Refraction: -4.5 -0.25 × 11°. Intraocular pressure 15 mmHg (non-contact tonometry). Pachymetry 516 µm.
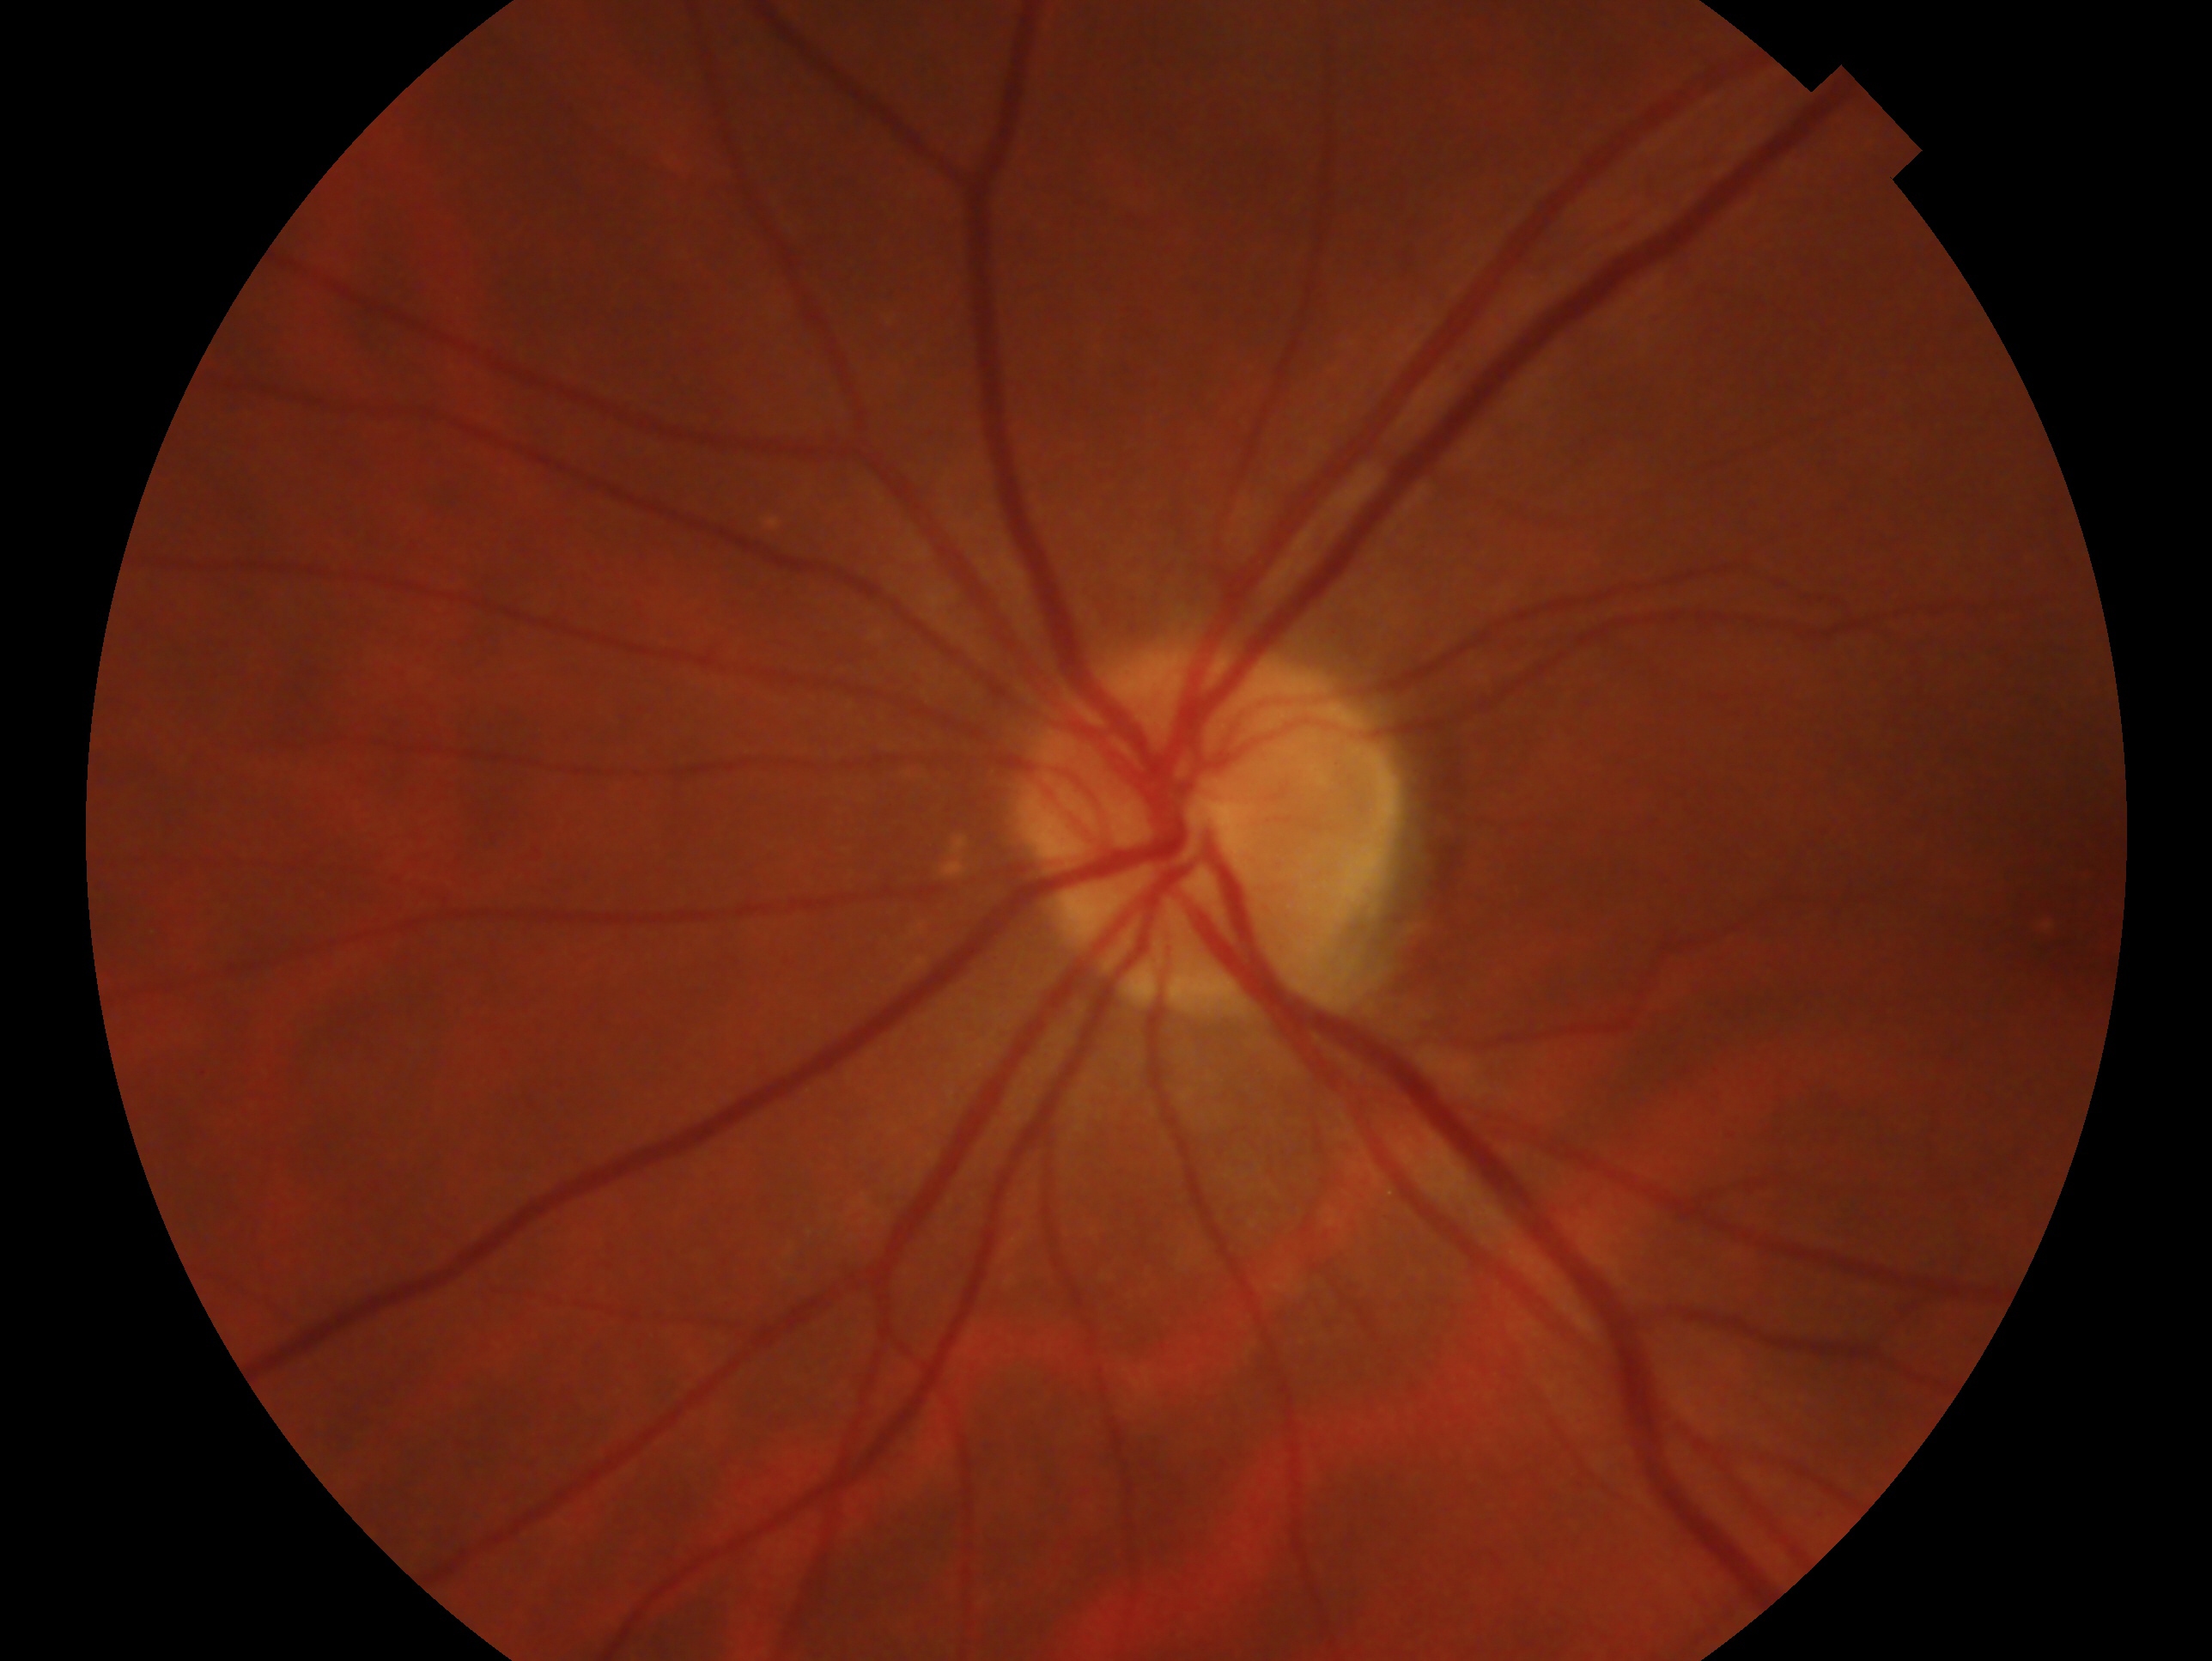 The image shows the left eye.
Clinical classification: no evidence of glaucoma.